Macula-centered field. 2361 by 1568 pixels. Fundus photo. Pupil-dilated. 50° field of view
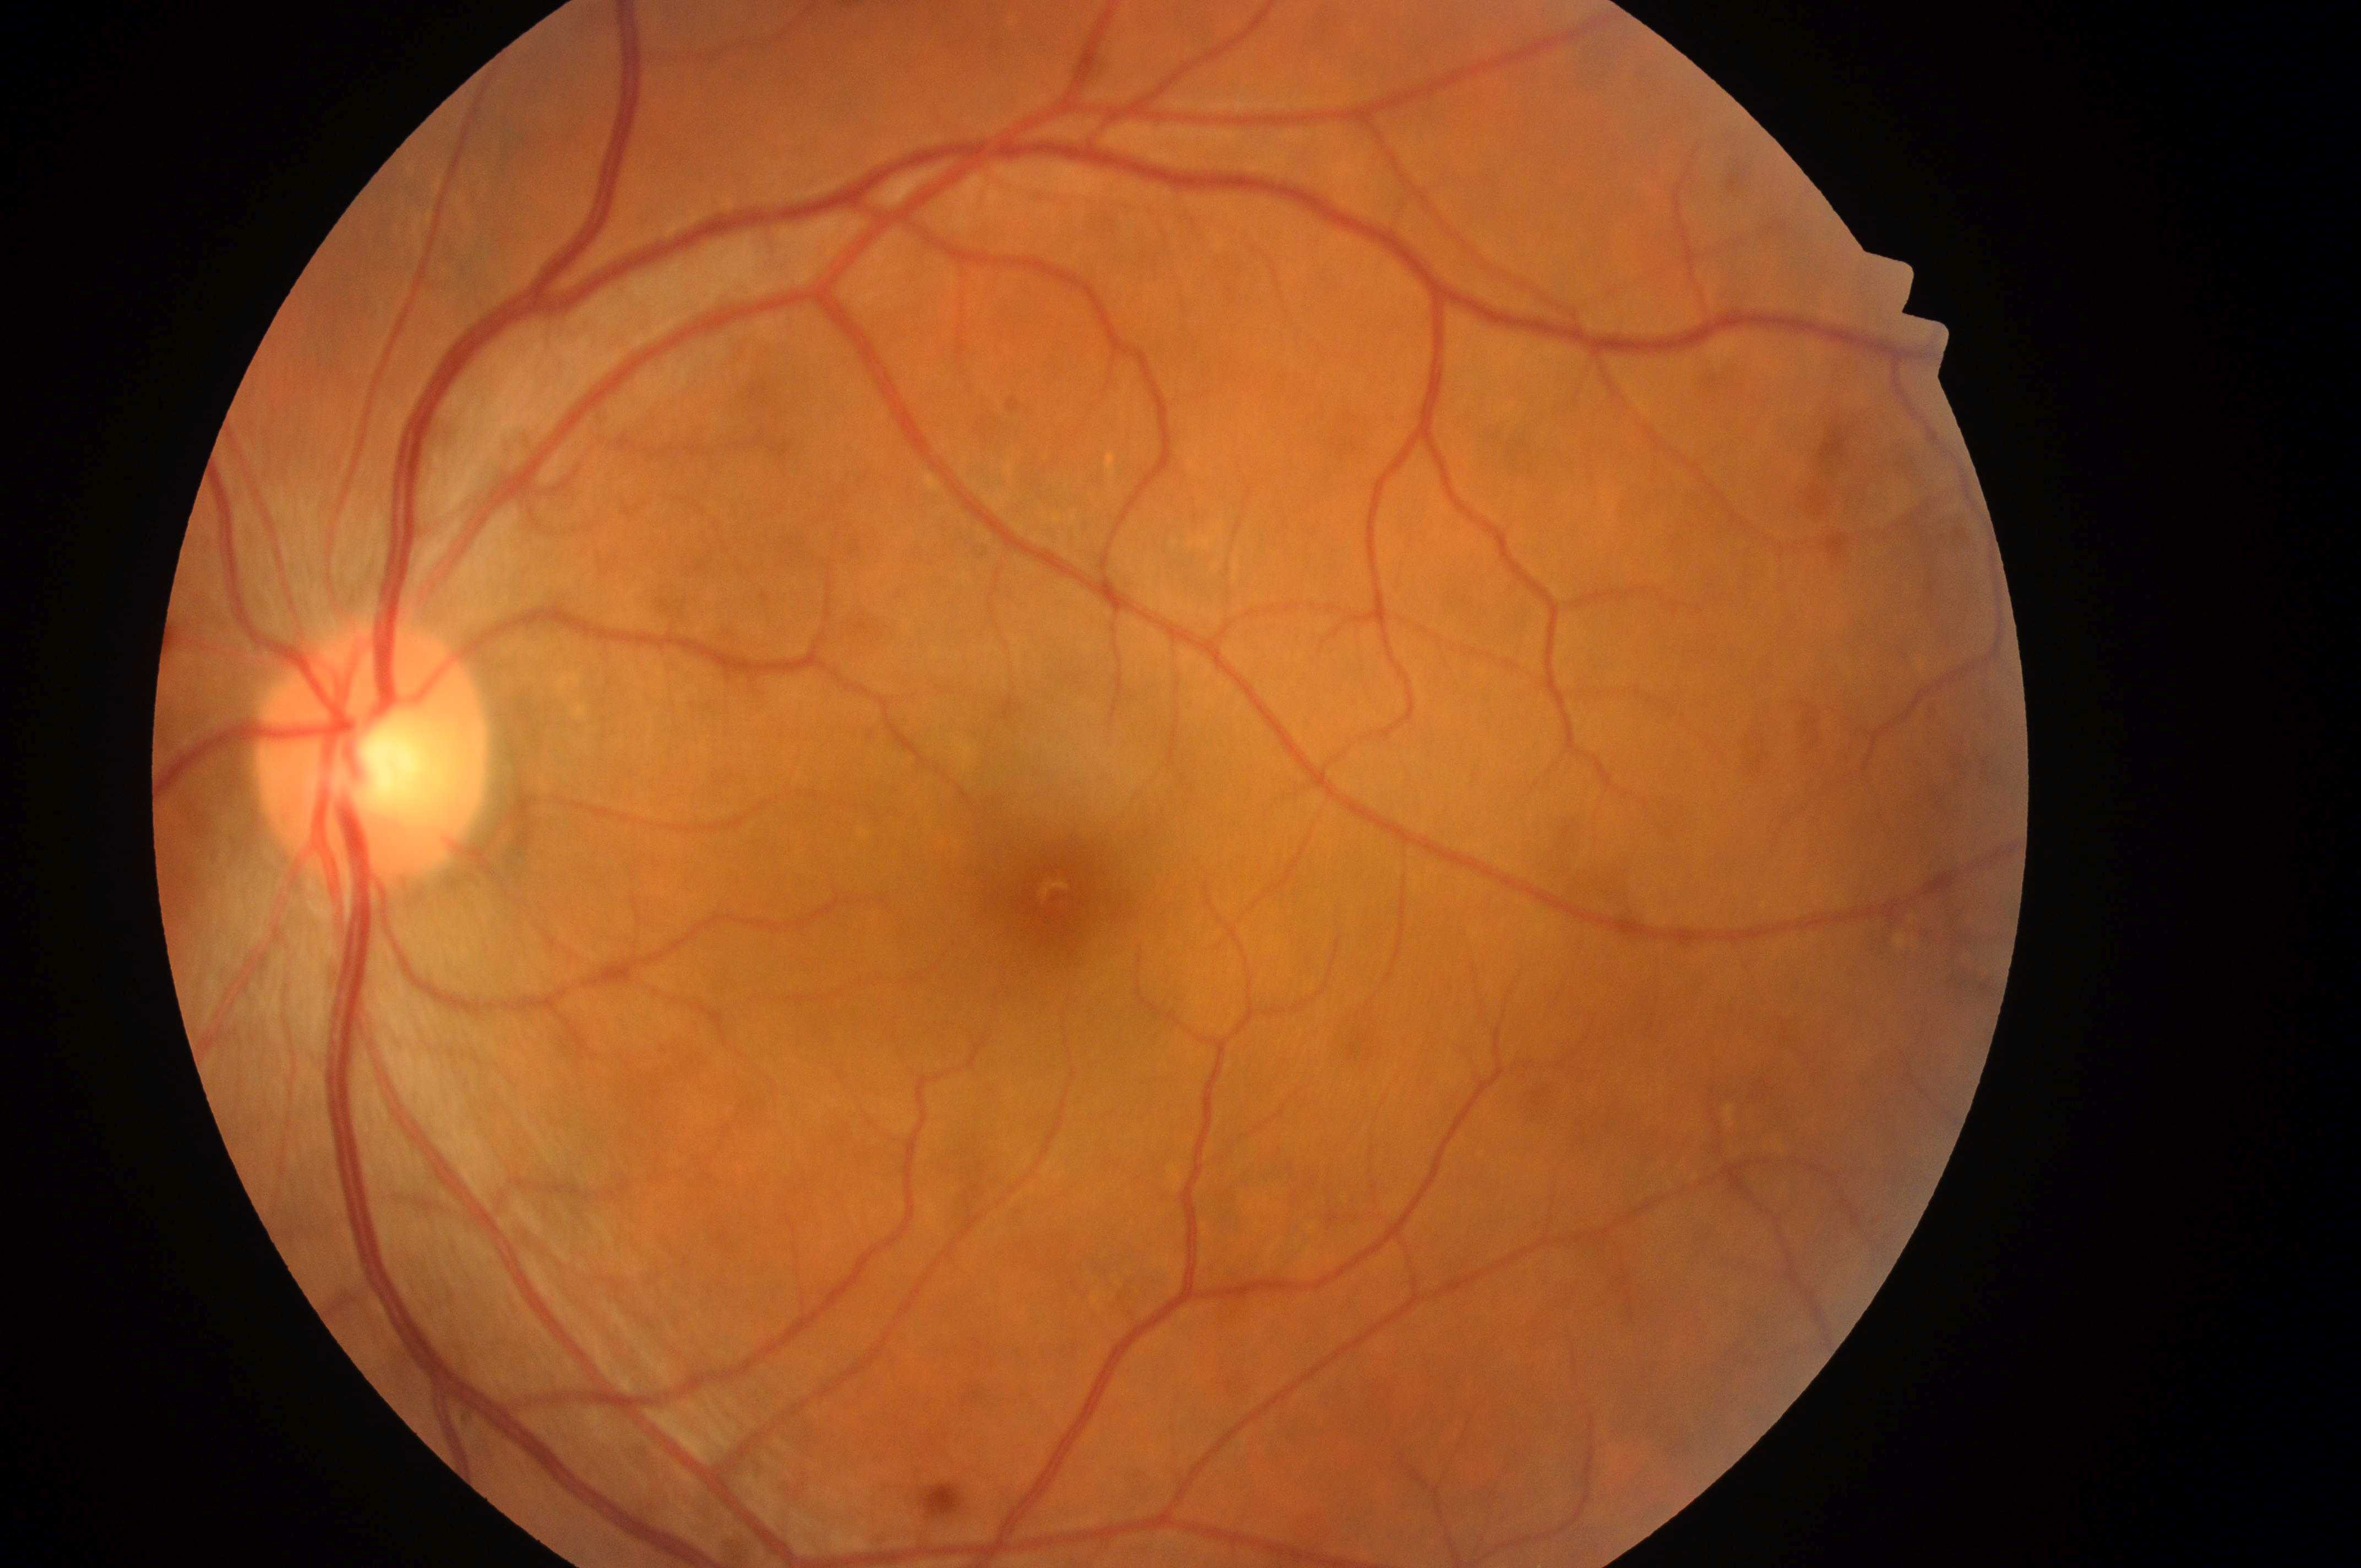

Findings:
• optic disc — (x=369, y=769)
• DME grade — 0 (no risk)
• fovea center — (x=1056, y=897)
• laterality — left eye
• DR grade — 0 (no apparent retinopathy)